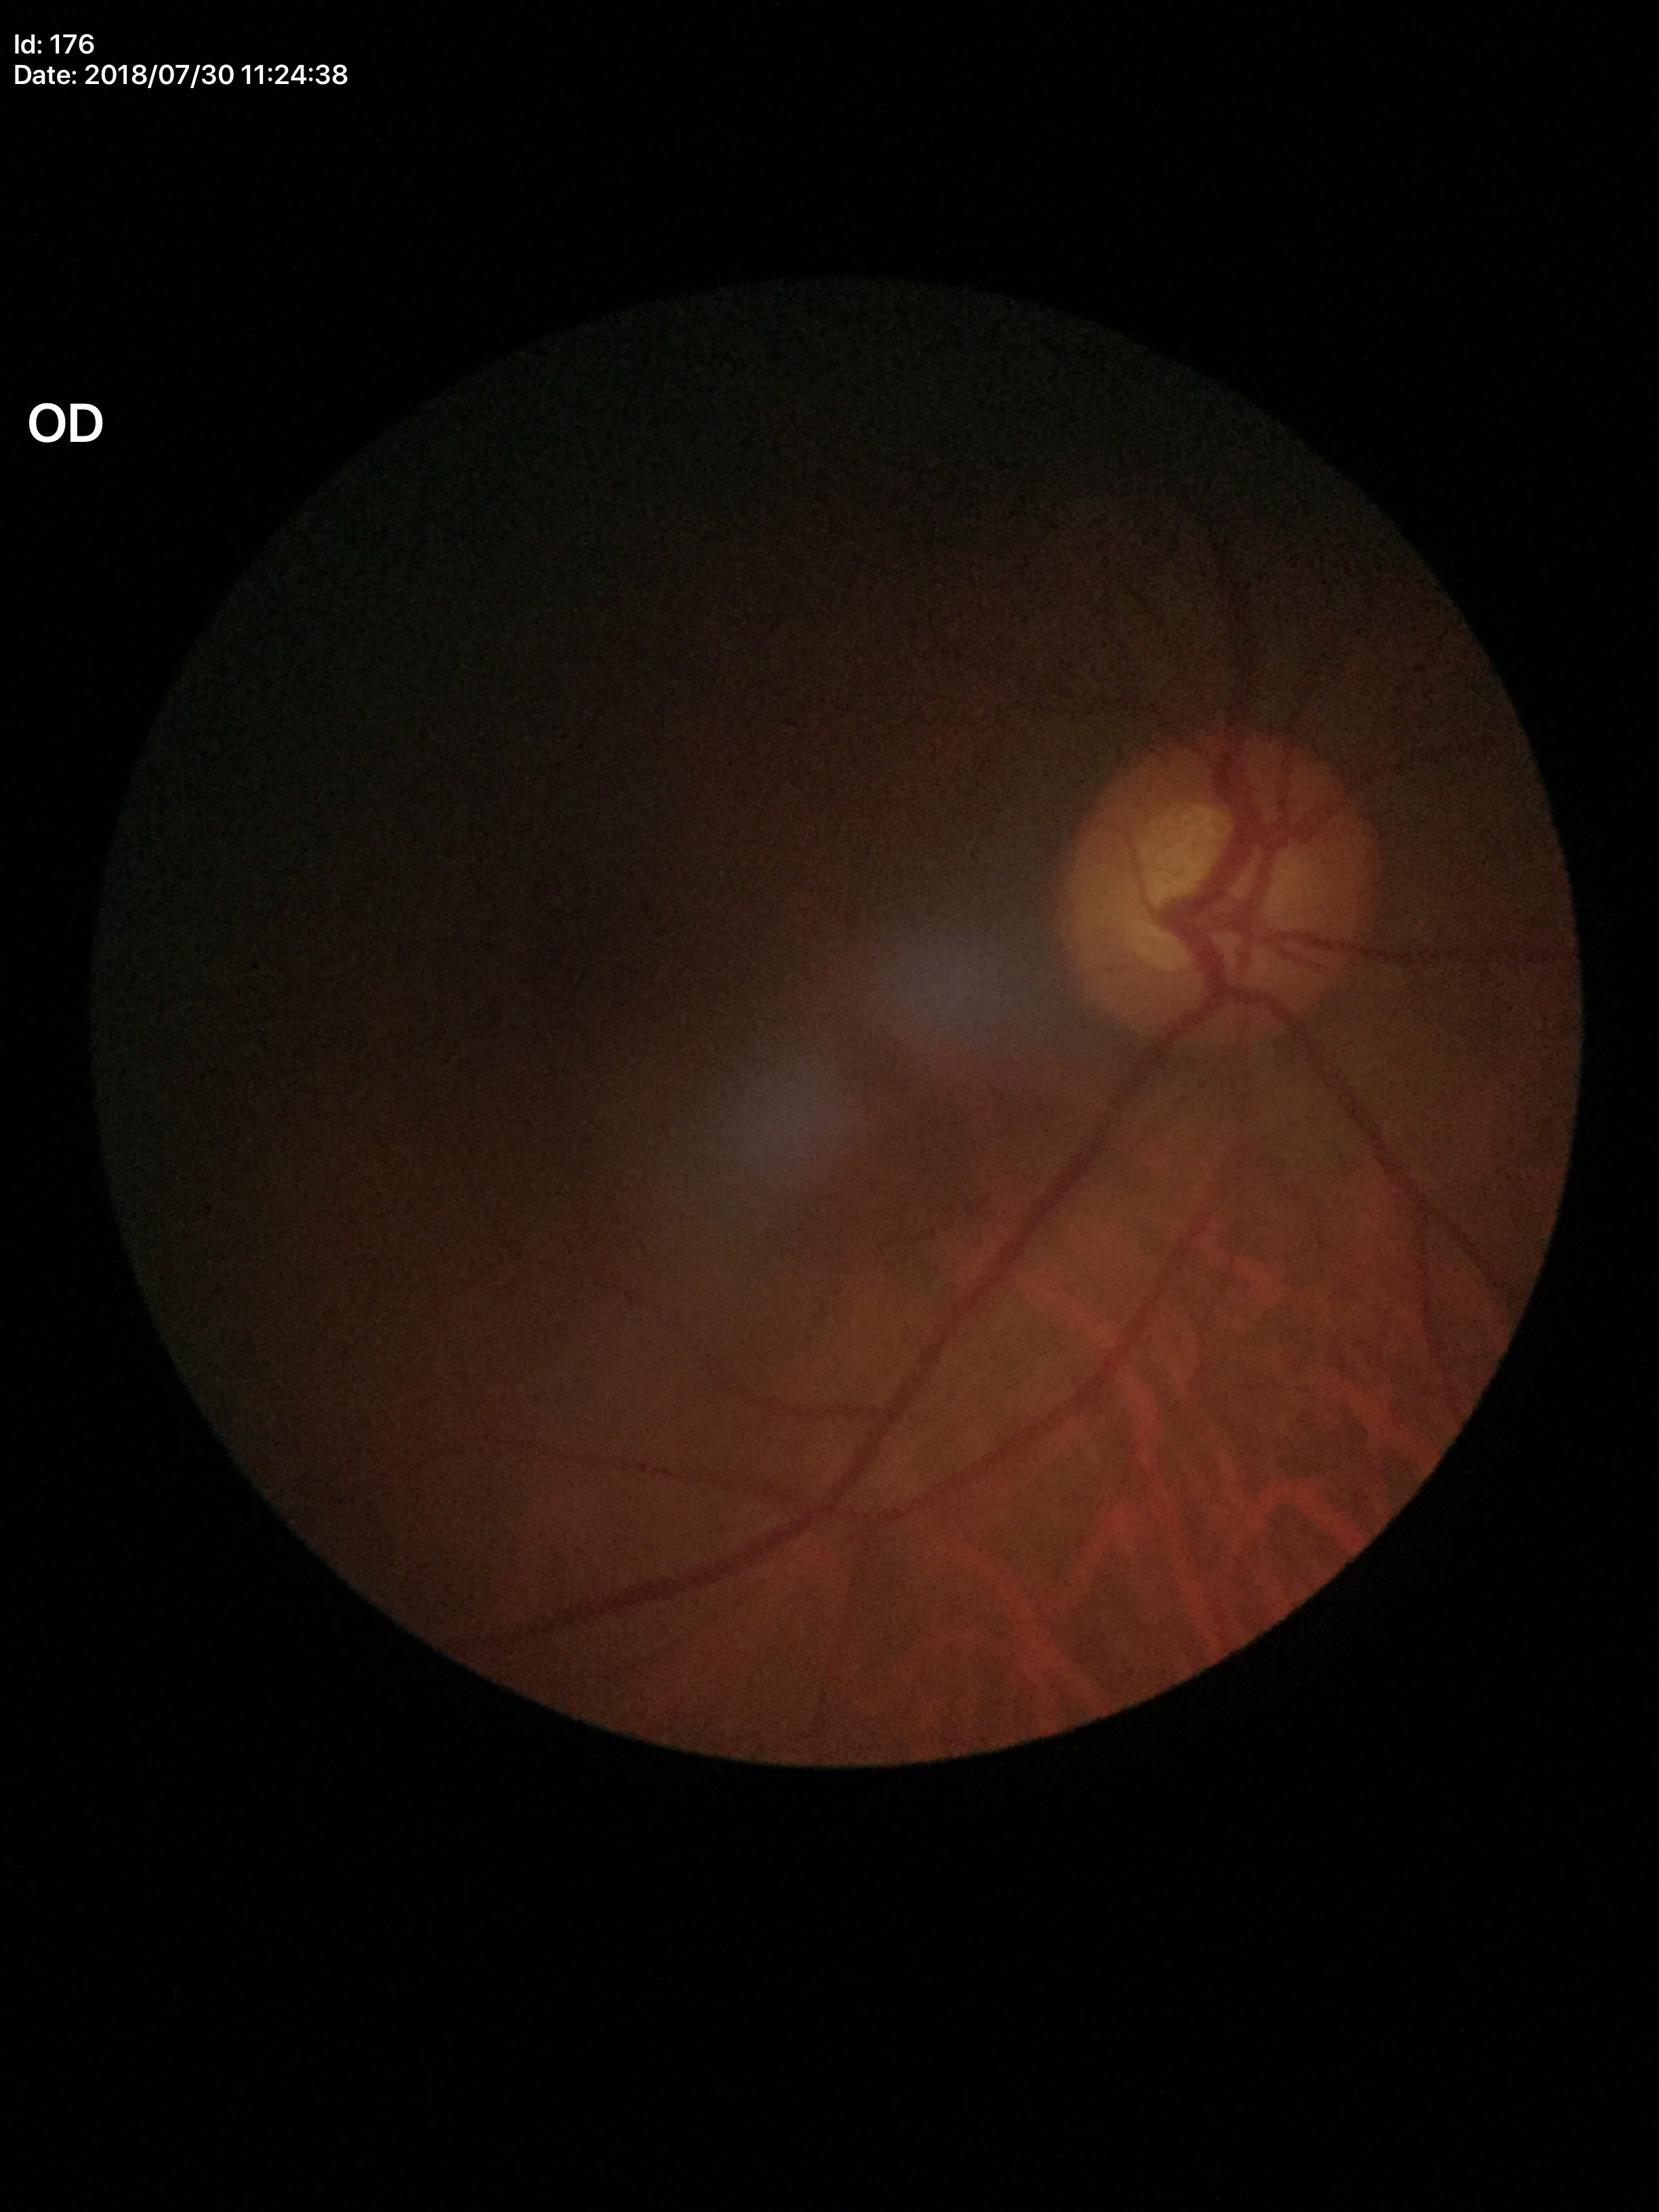
VCDR is 0.58.
Glaucoma decision: negative.
HCDR is 0.58.